Wide-field fundus photograph of an infant — 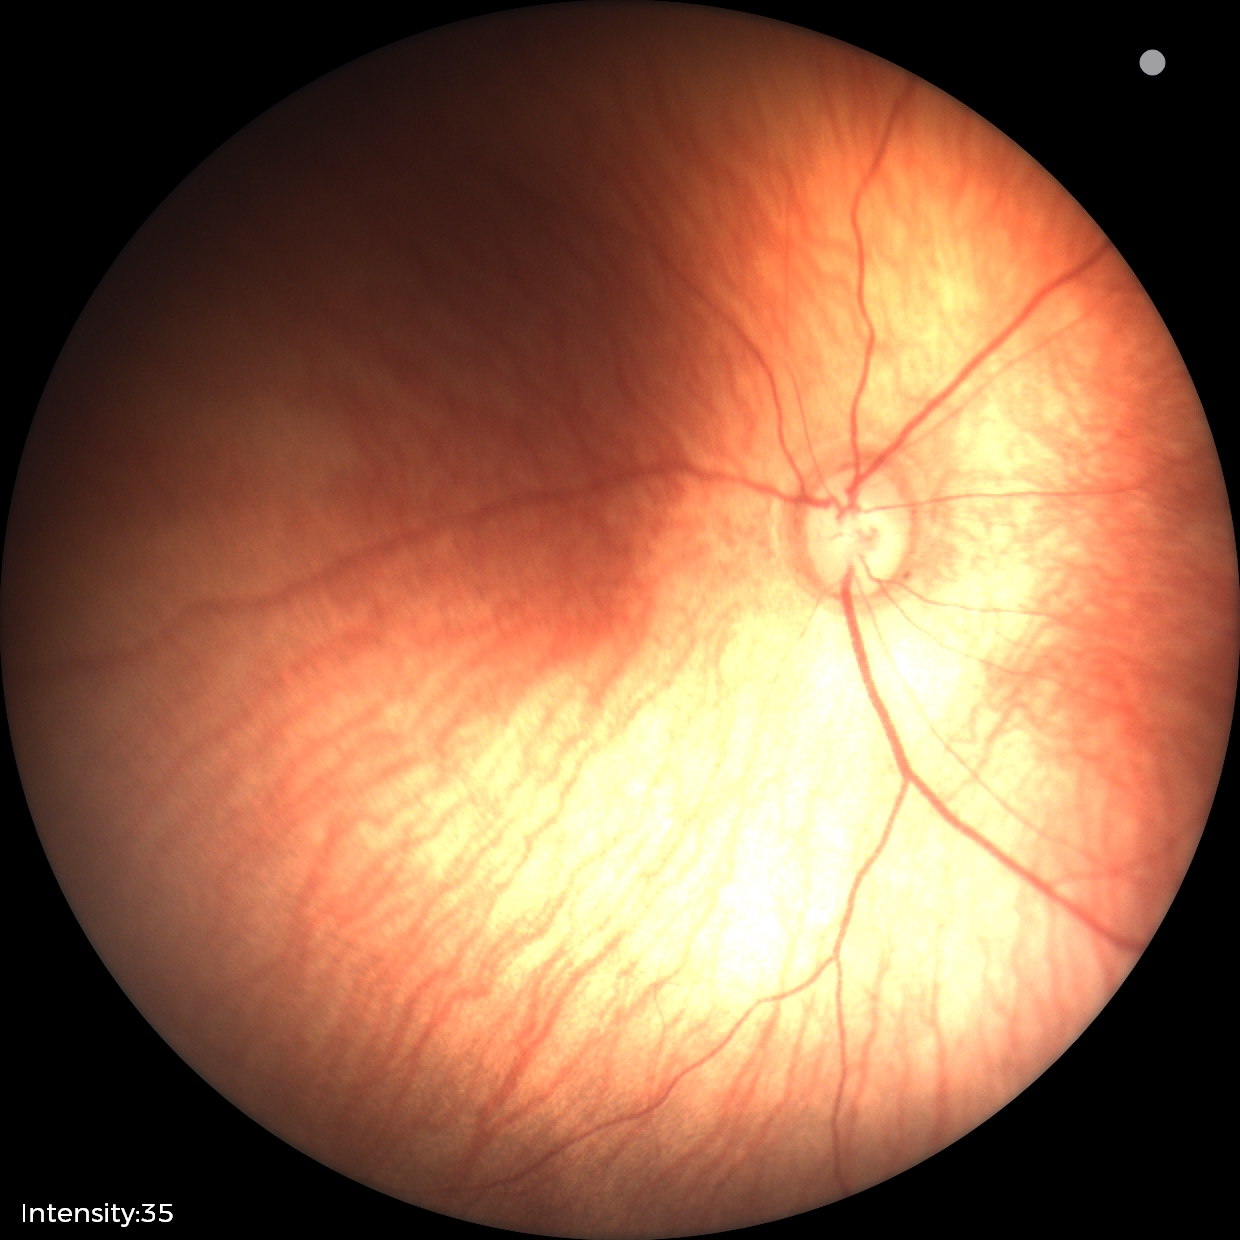 Impression: physiological appearance with no retinal pathology.